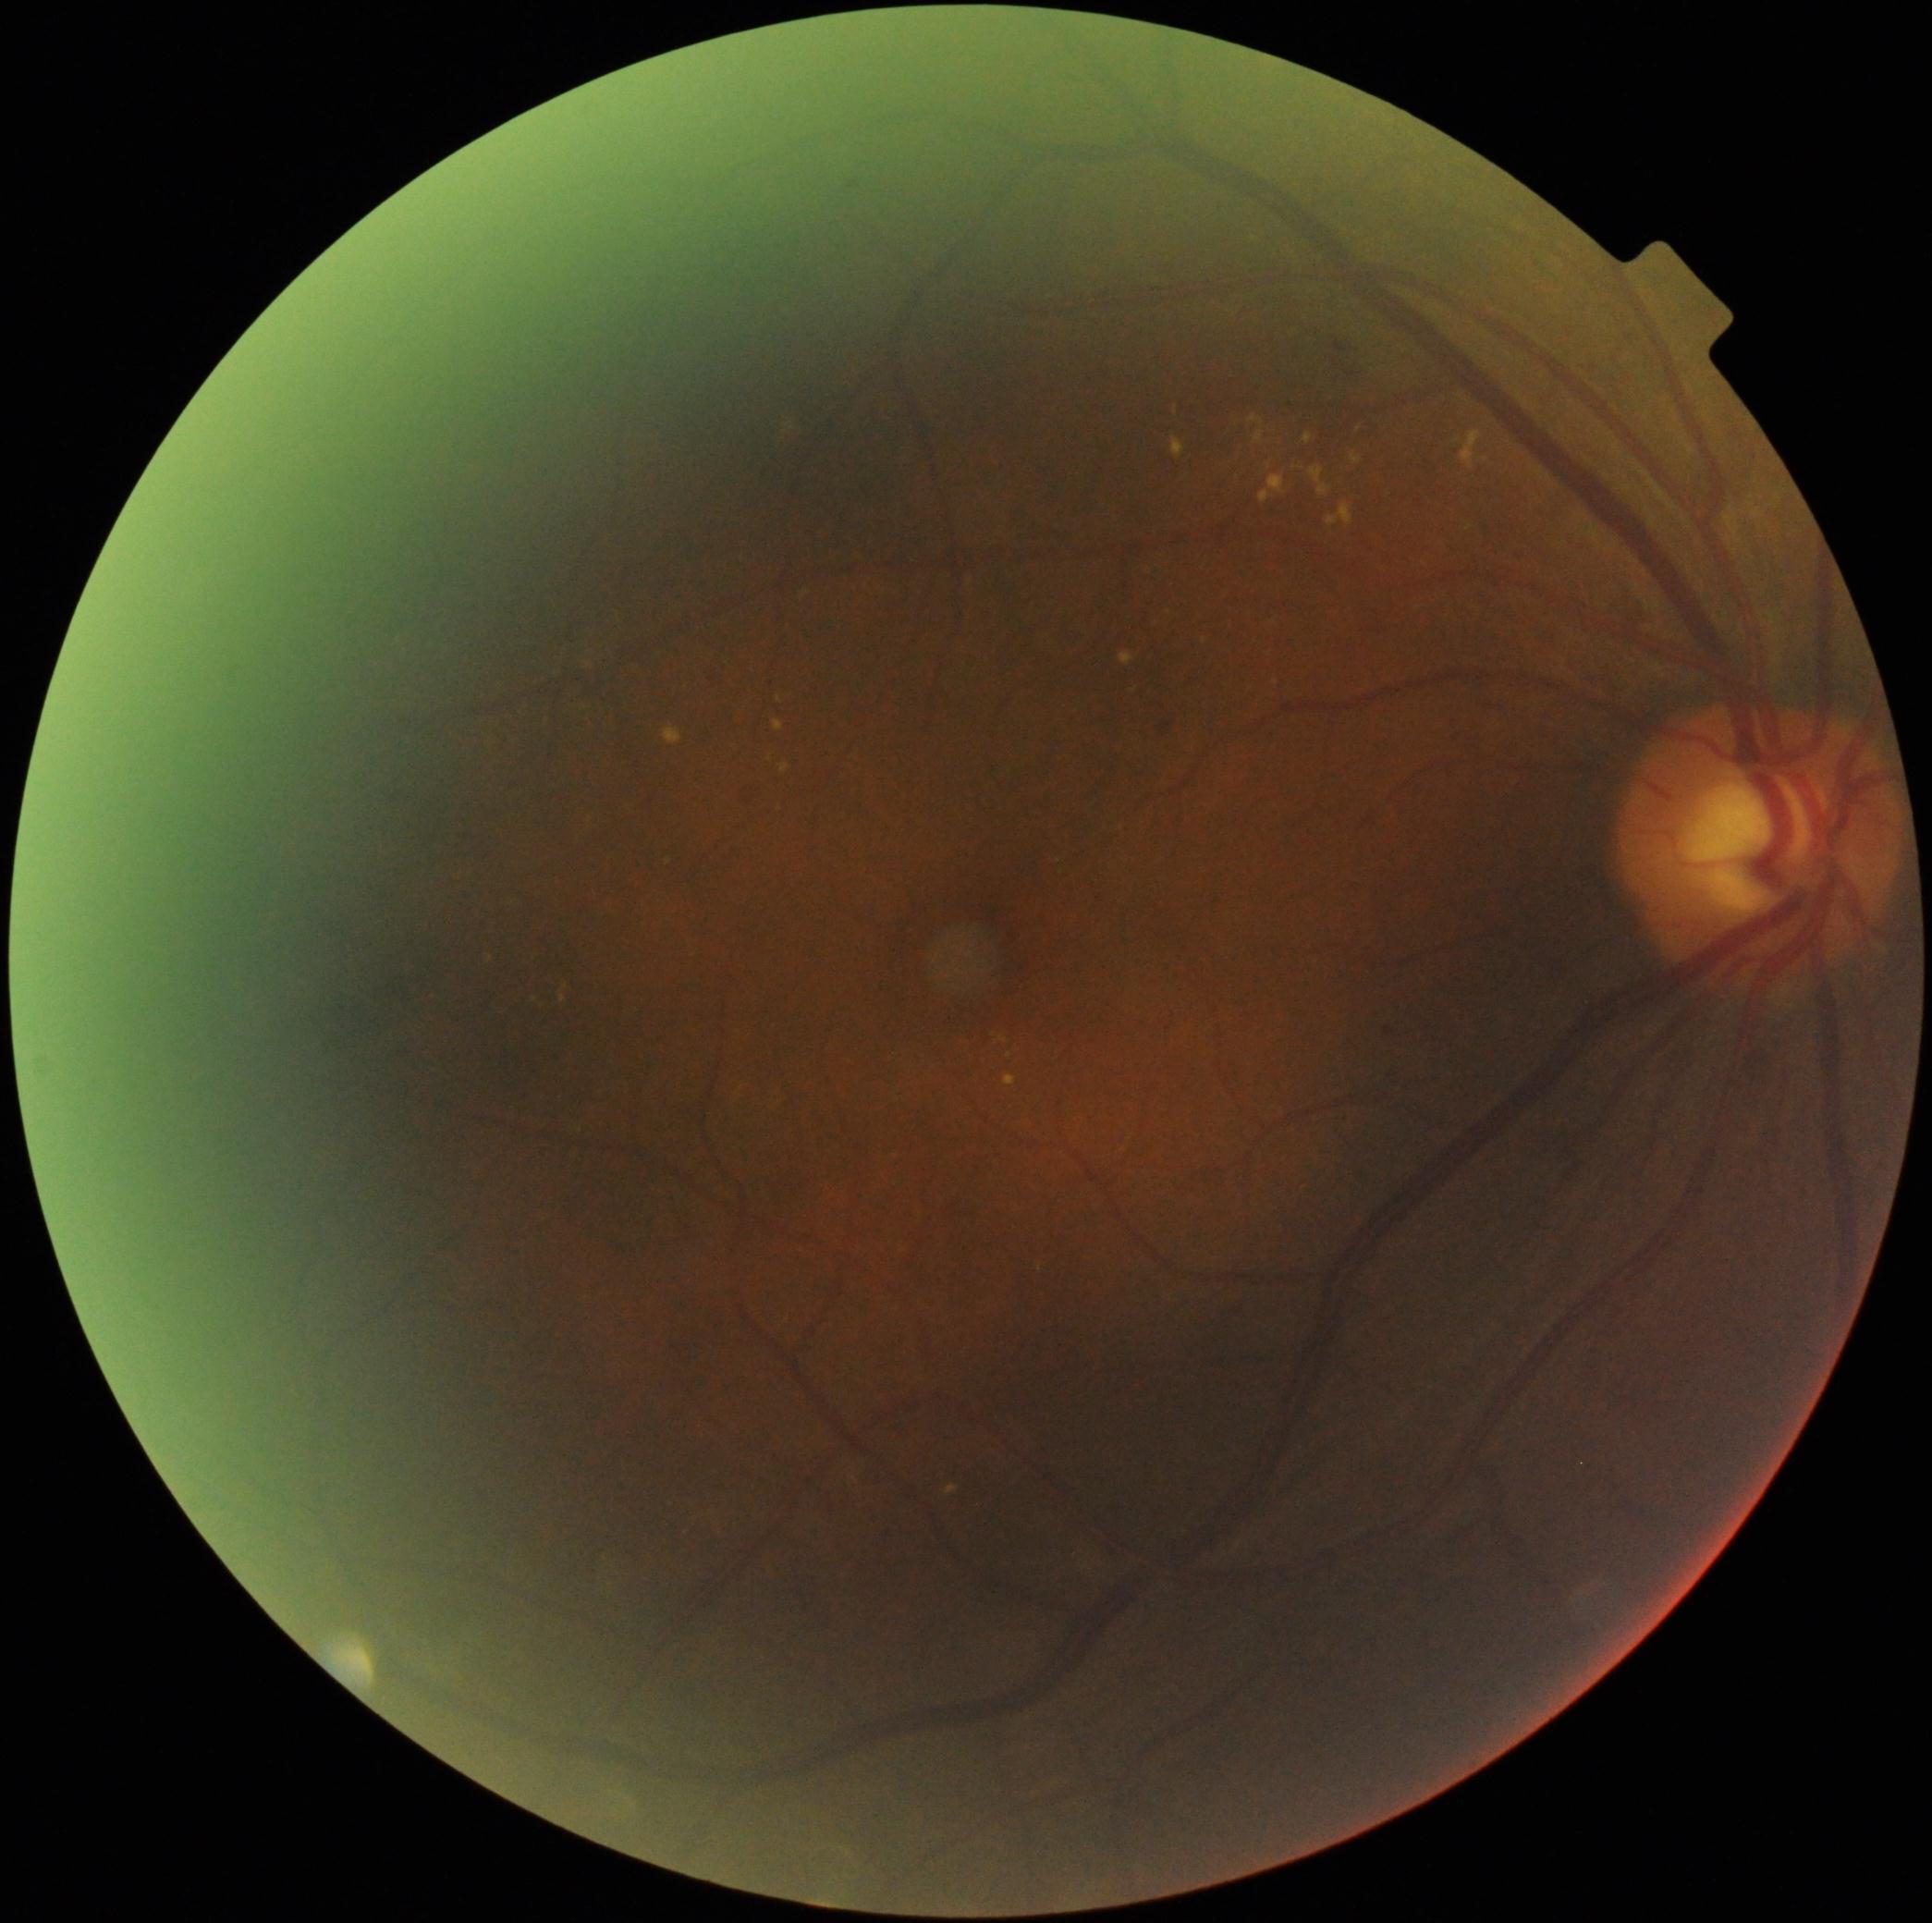

Annotations:
– retinopathy grade — 2/4 — more than just microaneurysms but less than severe NPDR